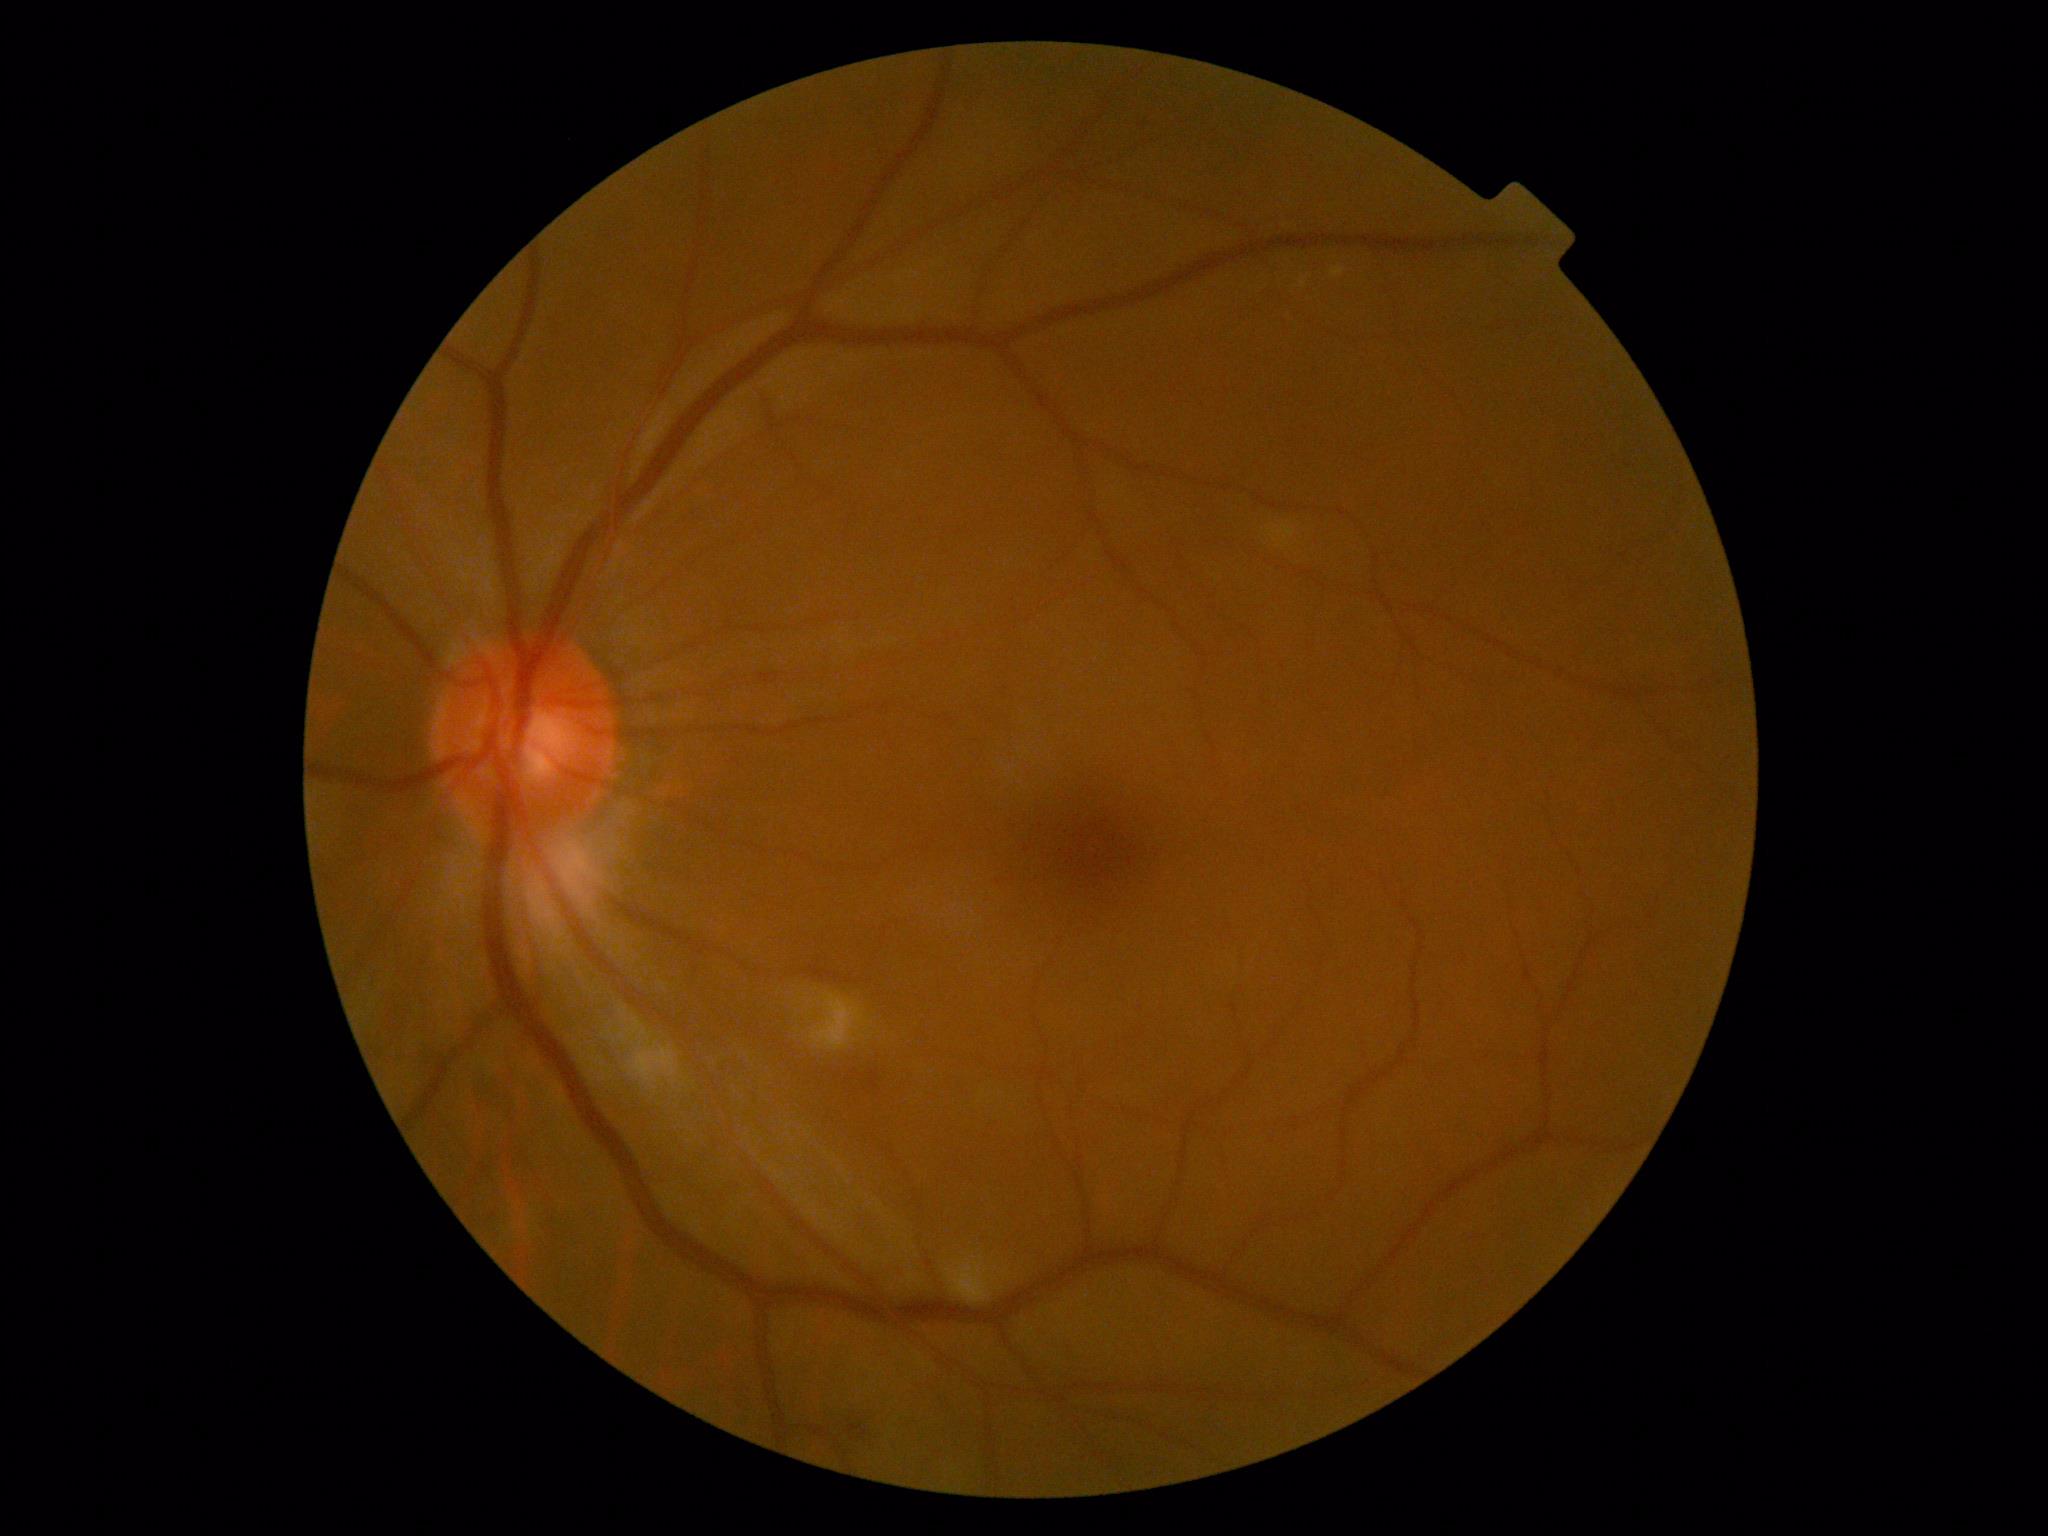
DR is grade 2 (moderate NPDR).